100° field of view (Phoenix ICON) · pediatric wide-field fundus photograph: 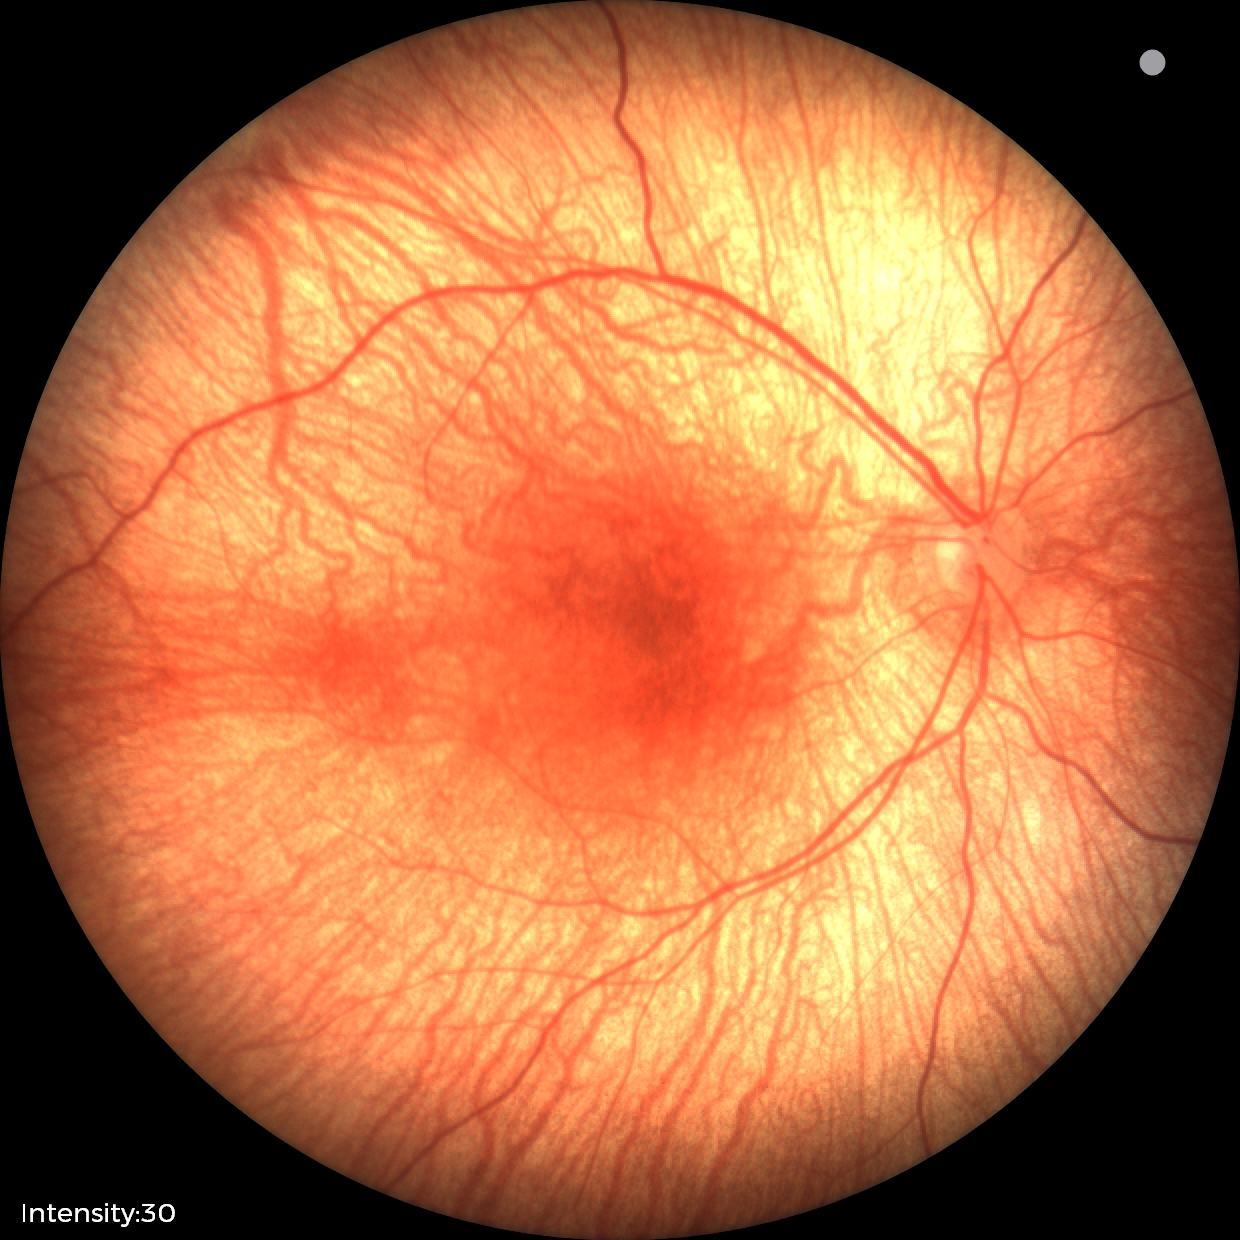

Screening examination diagnosed as physiological.